Mydriatic (tropicamide and phenylephrine) · 50° FOV · 2228x1652px.
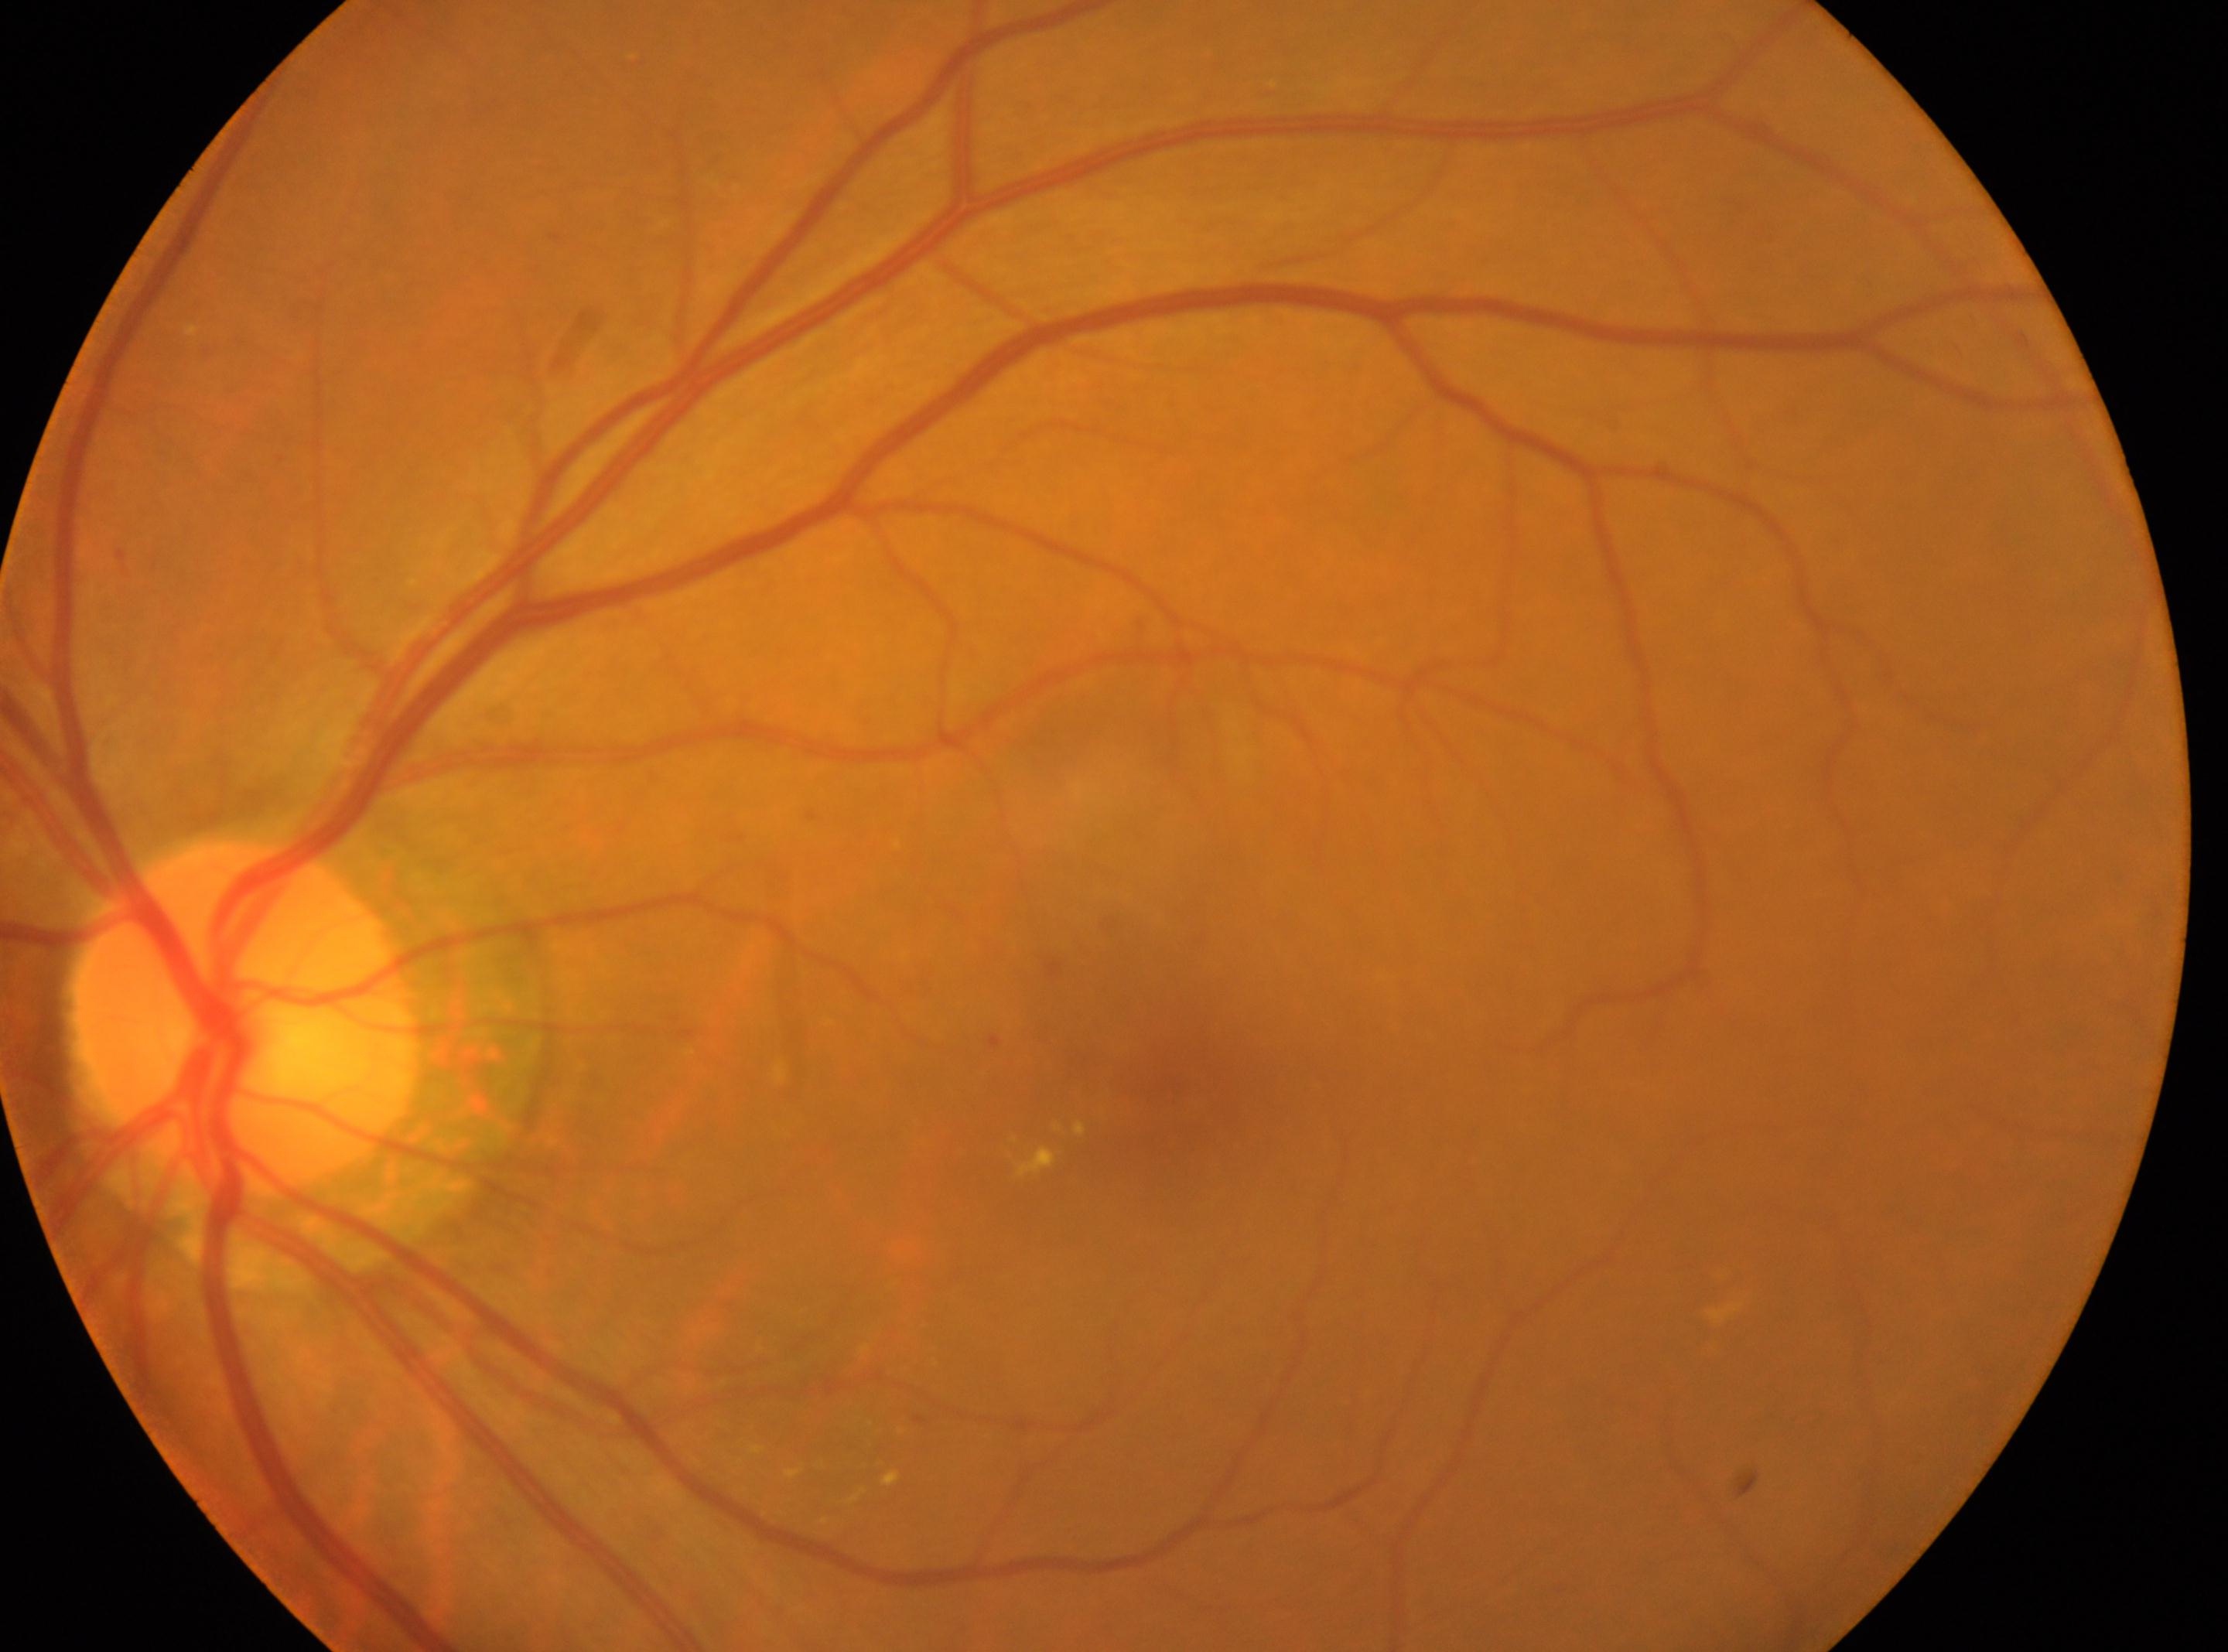
Q: Diabetic retinopathy severity?
A: grade 2 (moderate NPDR)
Q: Where is the optic disc?
A: x=241, y=1017
Q: Locate the fovea.
A: x=1167, y=1100
Q: Right or left eye?
A: left